Camera: Clarity RetCam 3 (130° FOV); pediatric retinal photograph (wide-field); 640x480px: 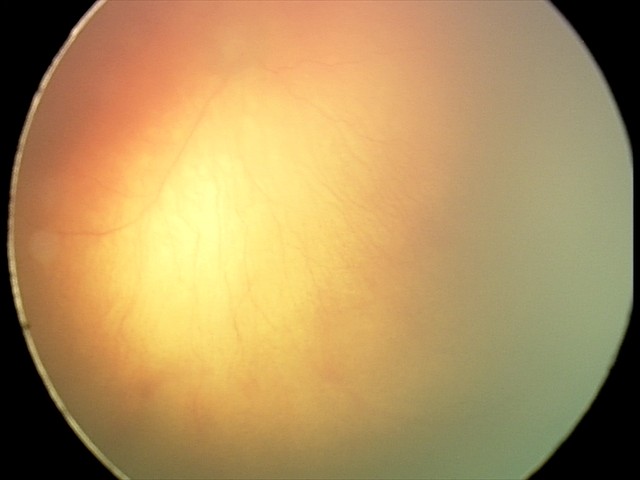
Impression: plus disease | A-ROP (aggressive ROP).